2048 by 1536 pixels: 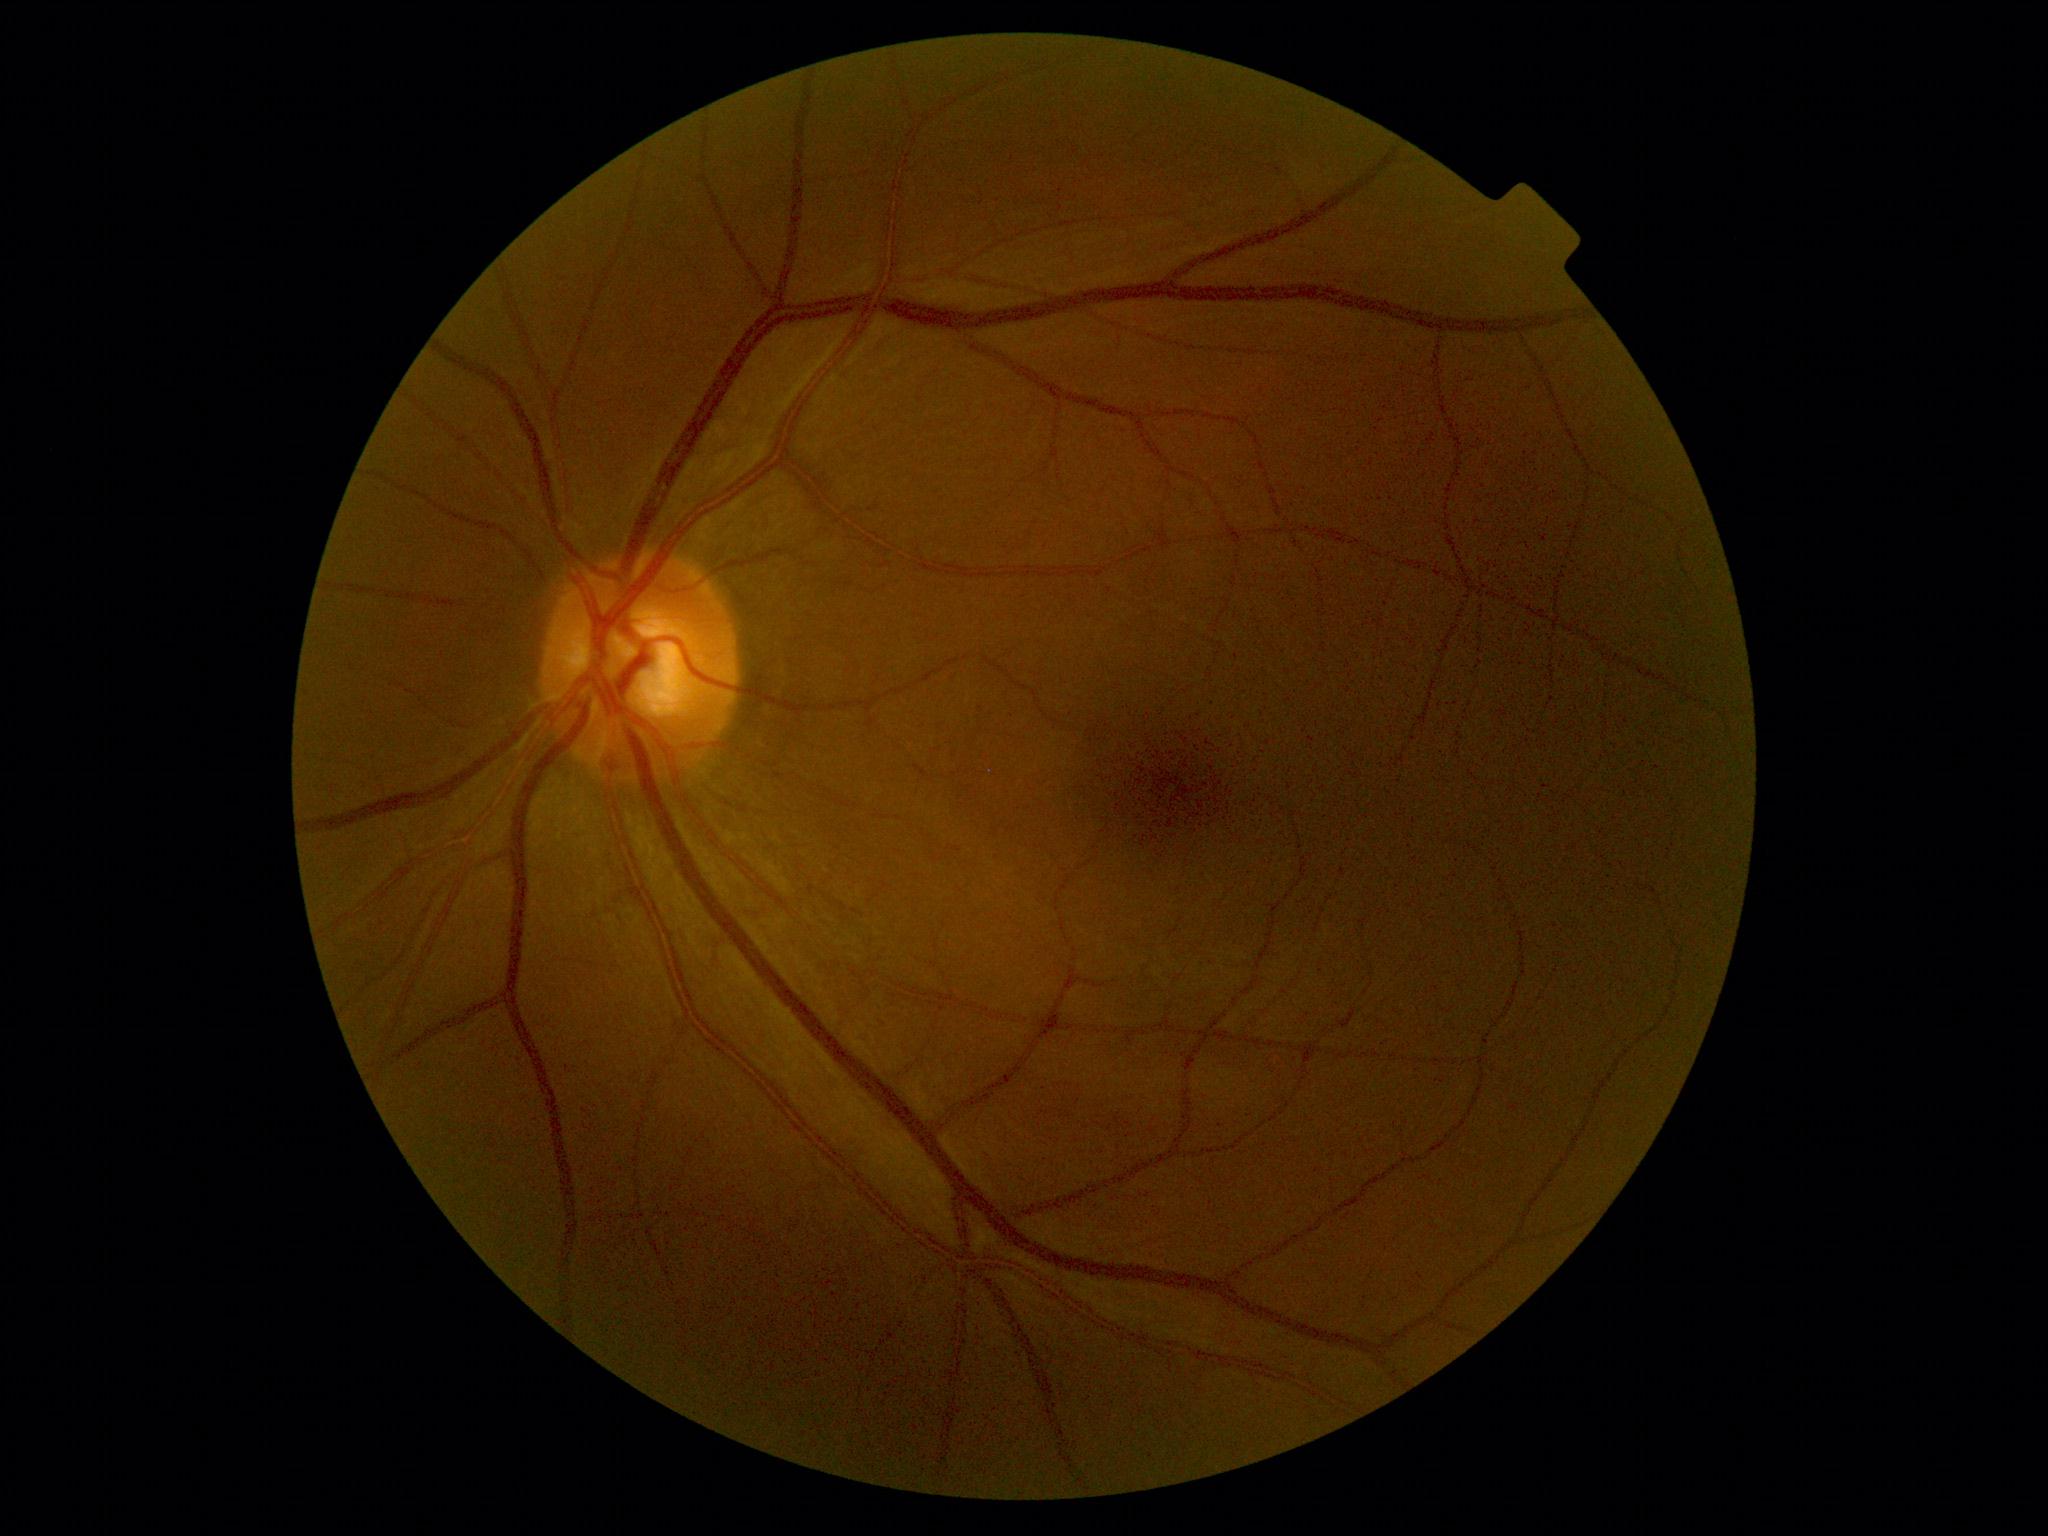
DR: grade 0. No apparent diabetic retinopathy.